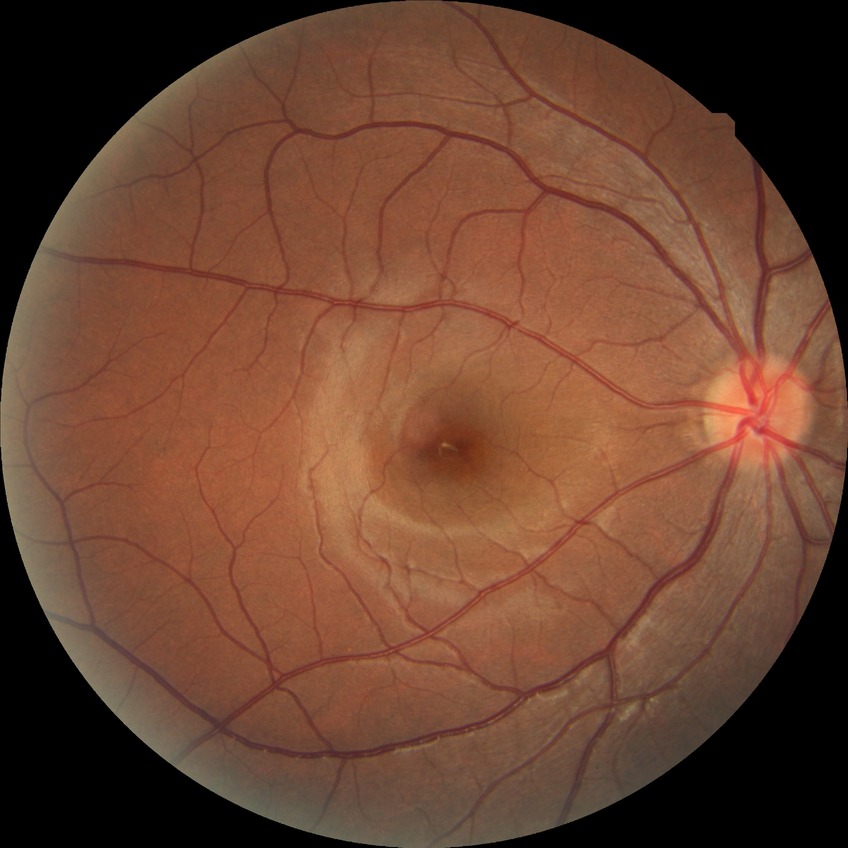

* diabetic retinopathy grade — no diabetic retinopathy